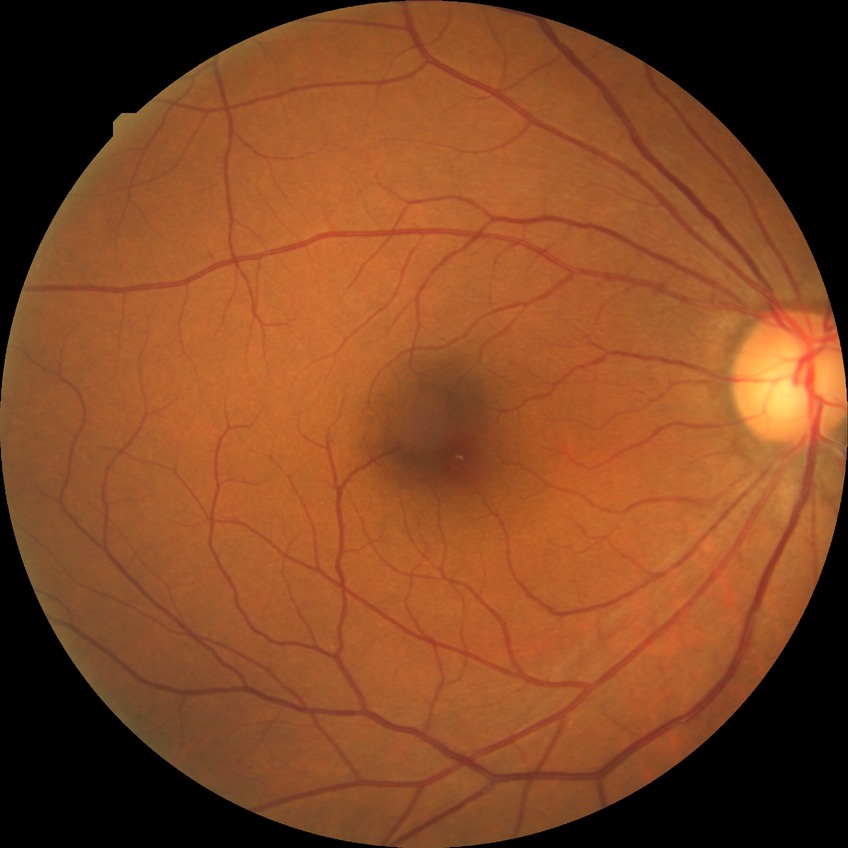 Diabetic retinopathy (DR) is no diabetic retinopathy (NDR).